1240 by 1240 pixels; wide-field fundus image from infant ROP screening.
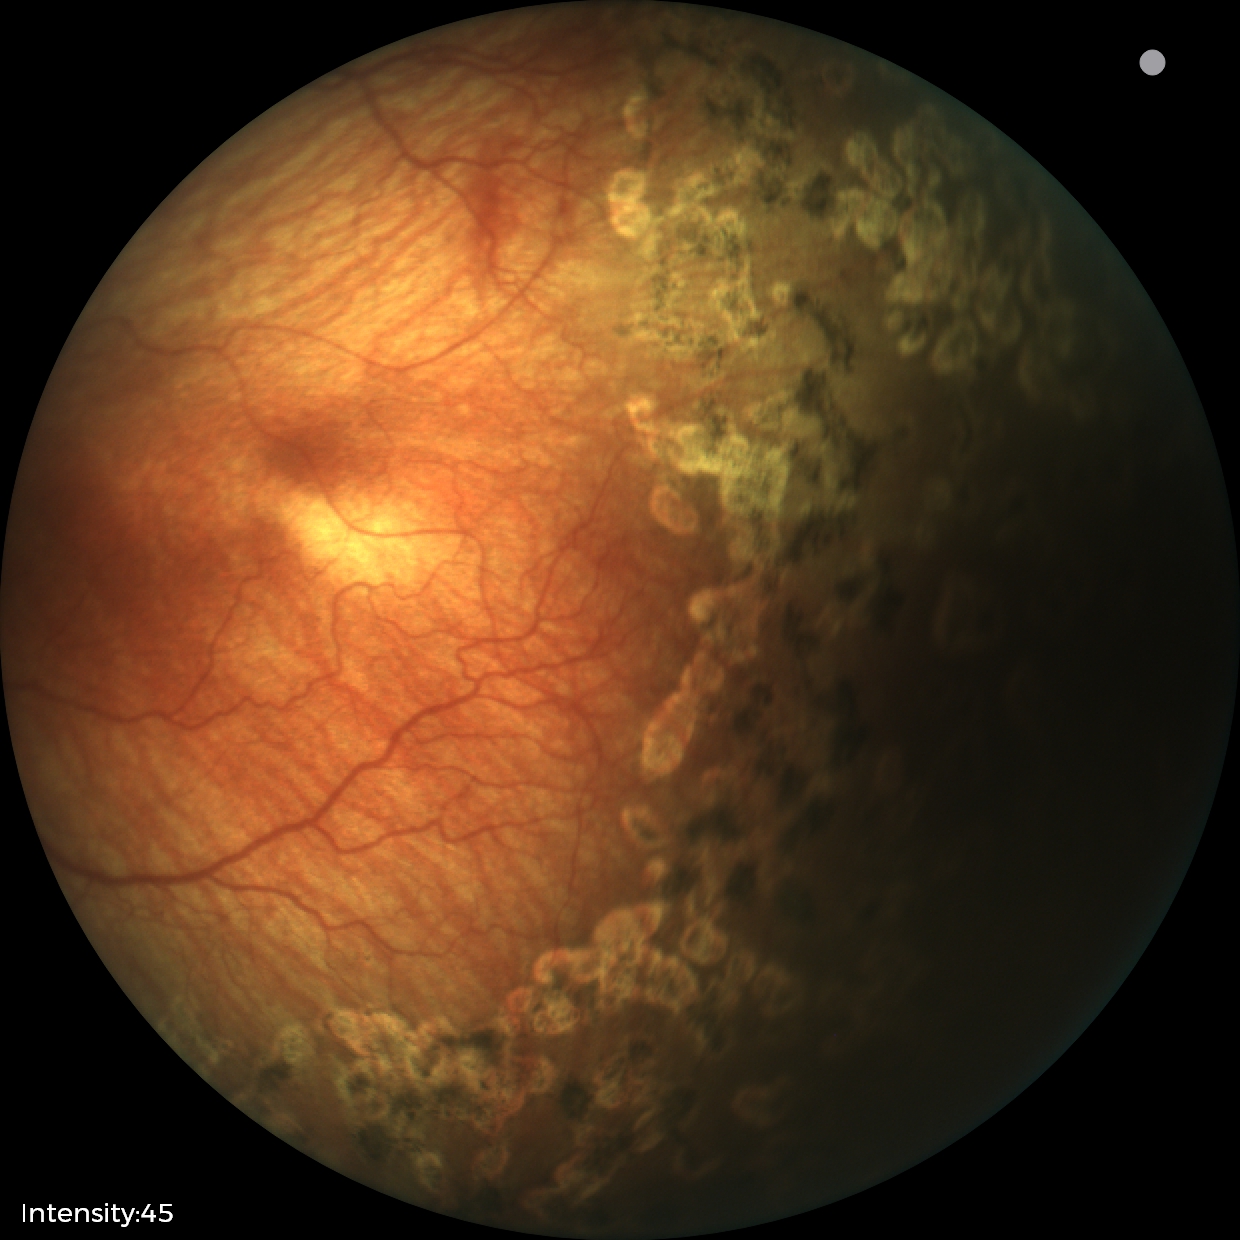 From an examination with diagnosis of status post ROP.